45-degree field of view:
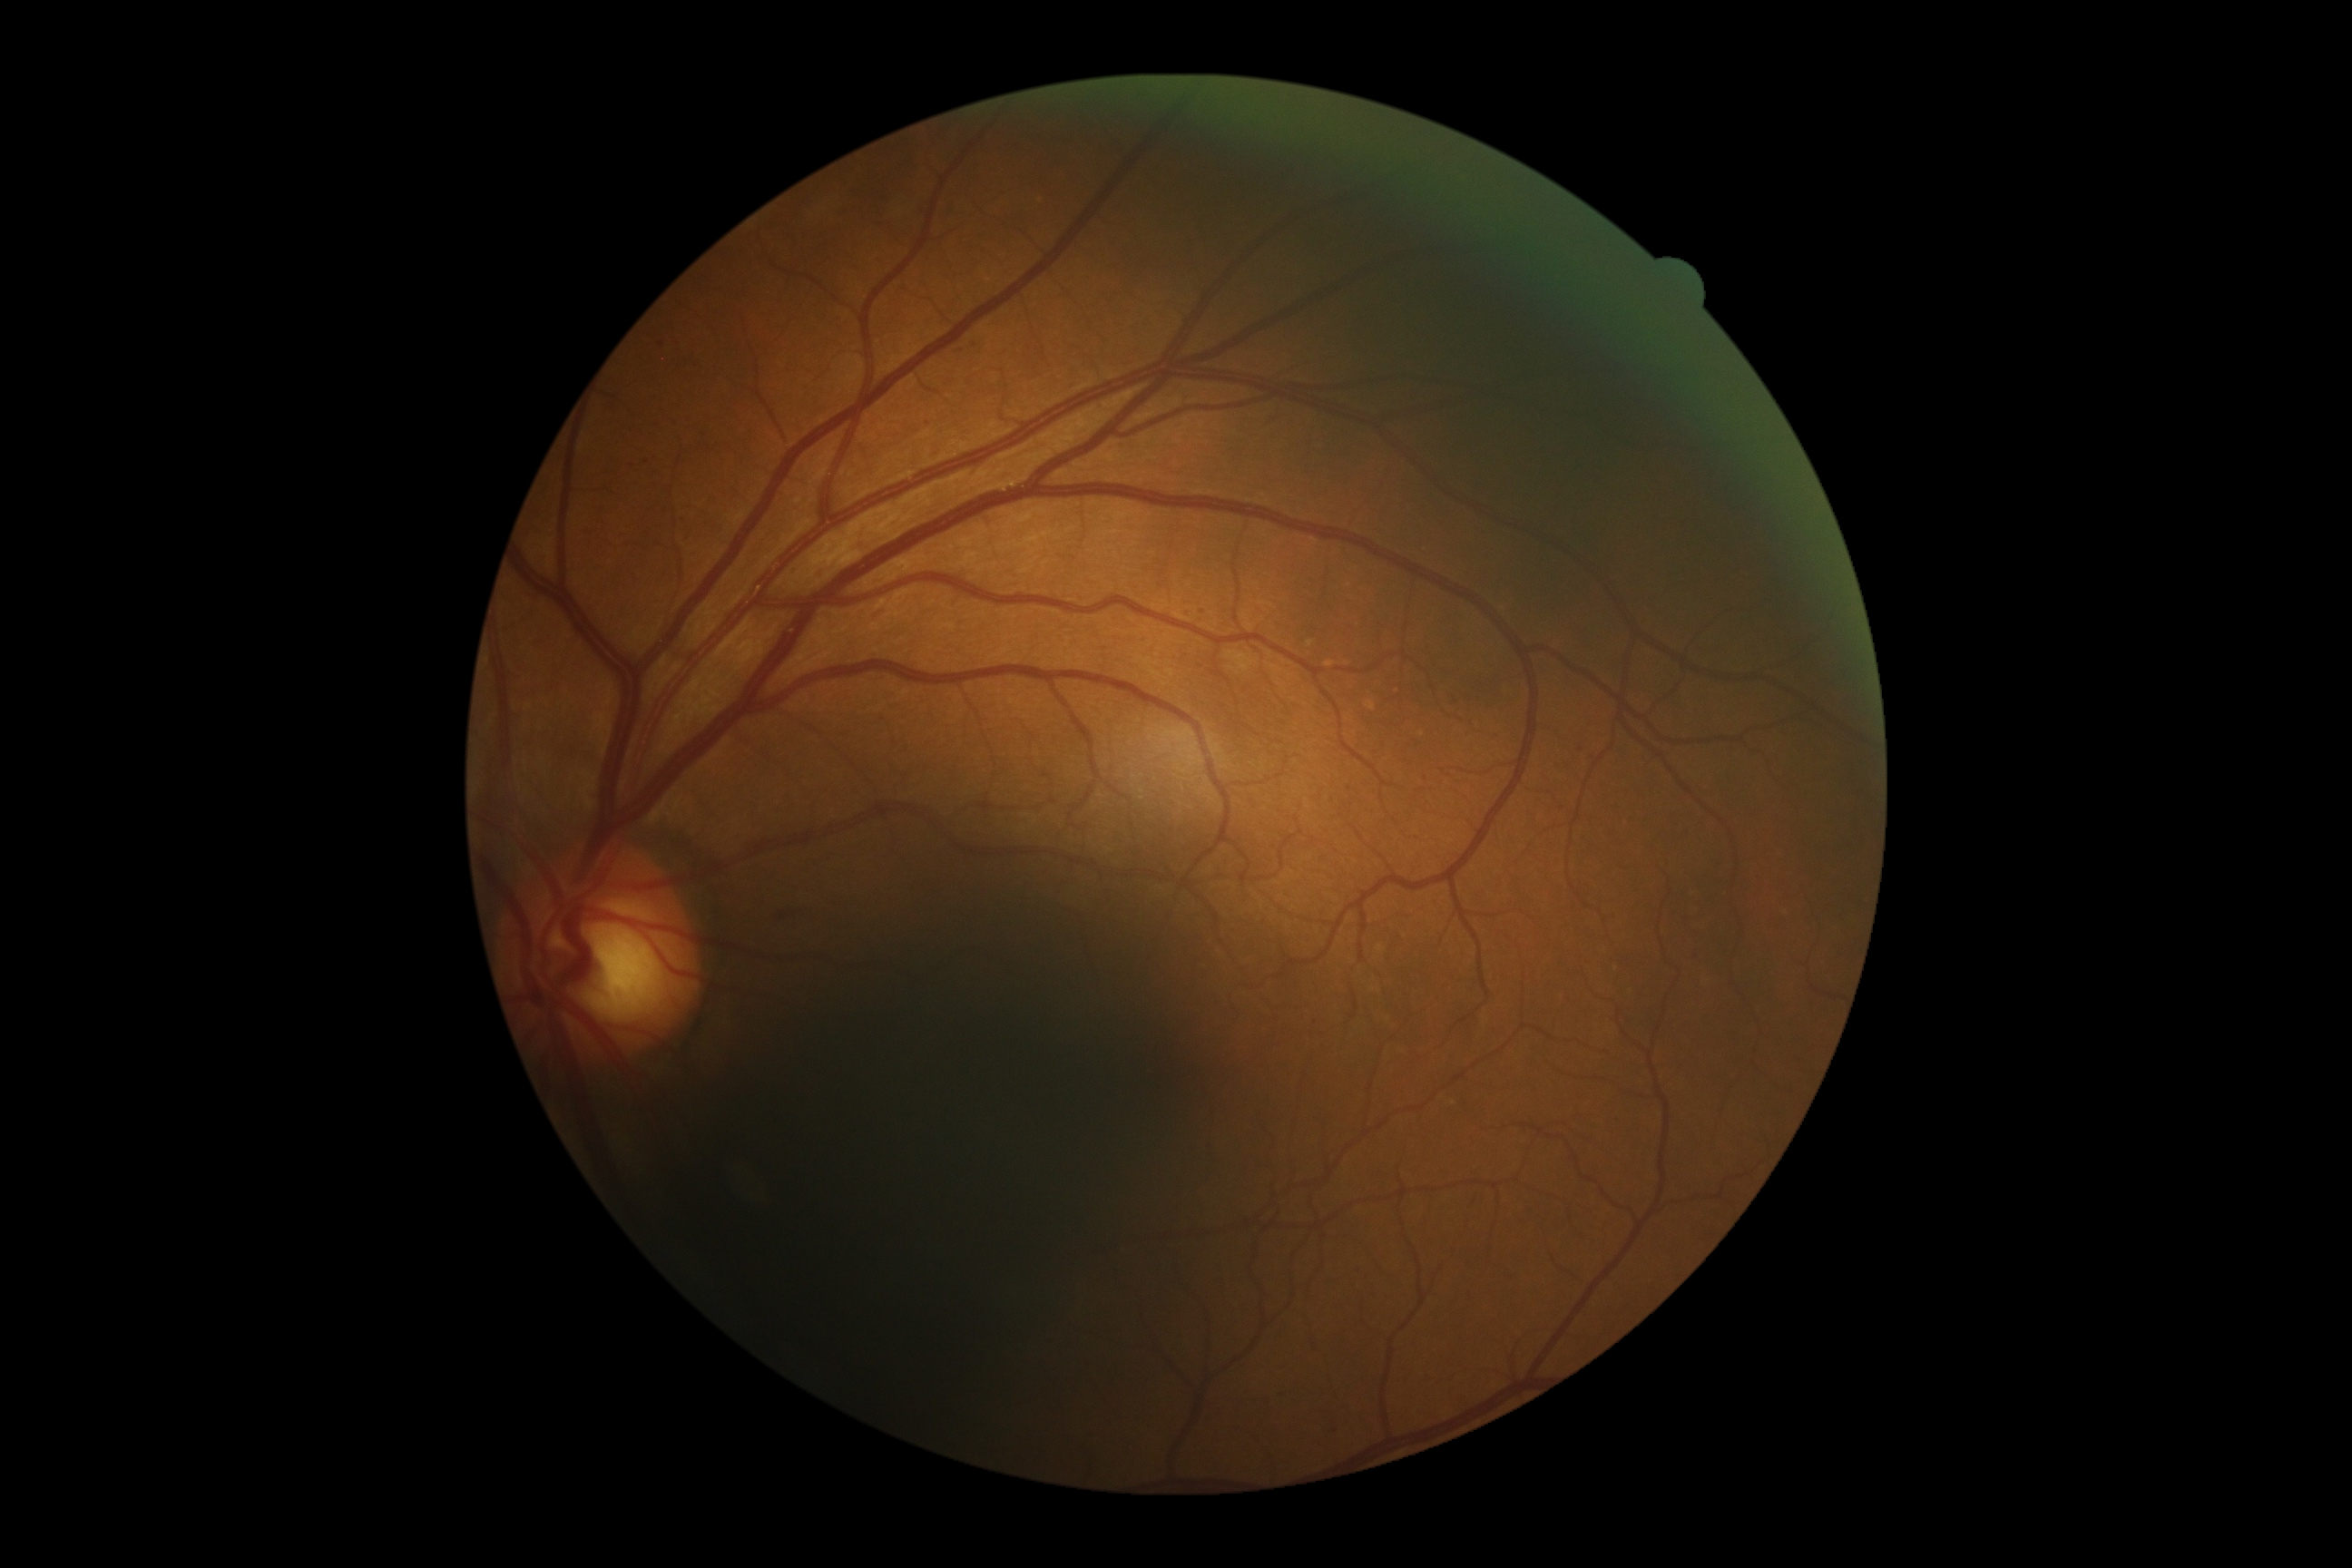

* DR class: non-proliferative diabetic retinopathy
* DR: grade 2 (moderate NPDR)